NIDEK AFC-230 fundus camera. Modified Davis grading. FOV: 45 degrees — 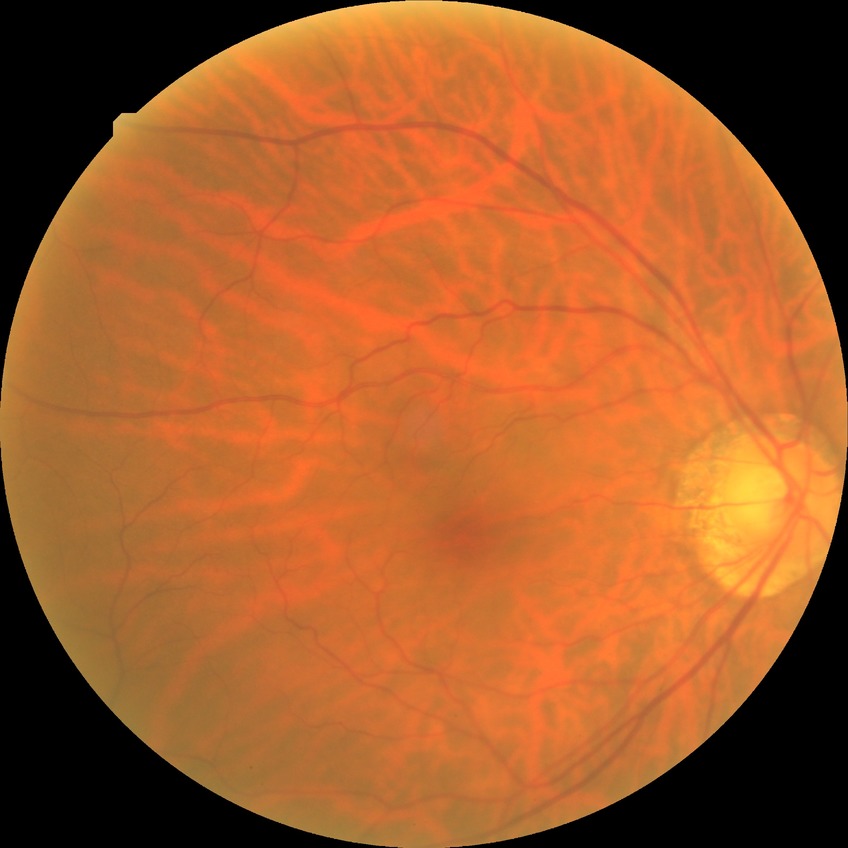

Diabetic retinopathy stage is no diabetic retinopathy.